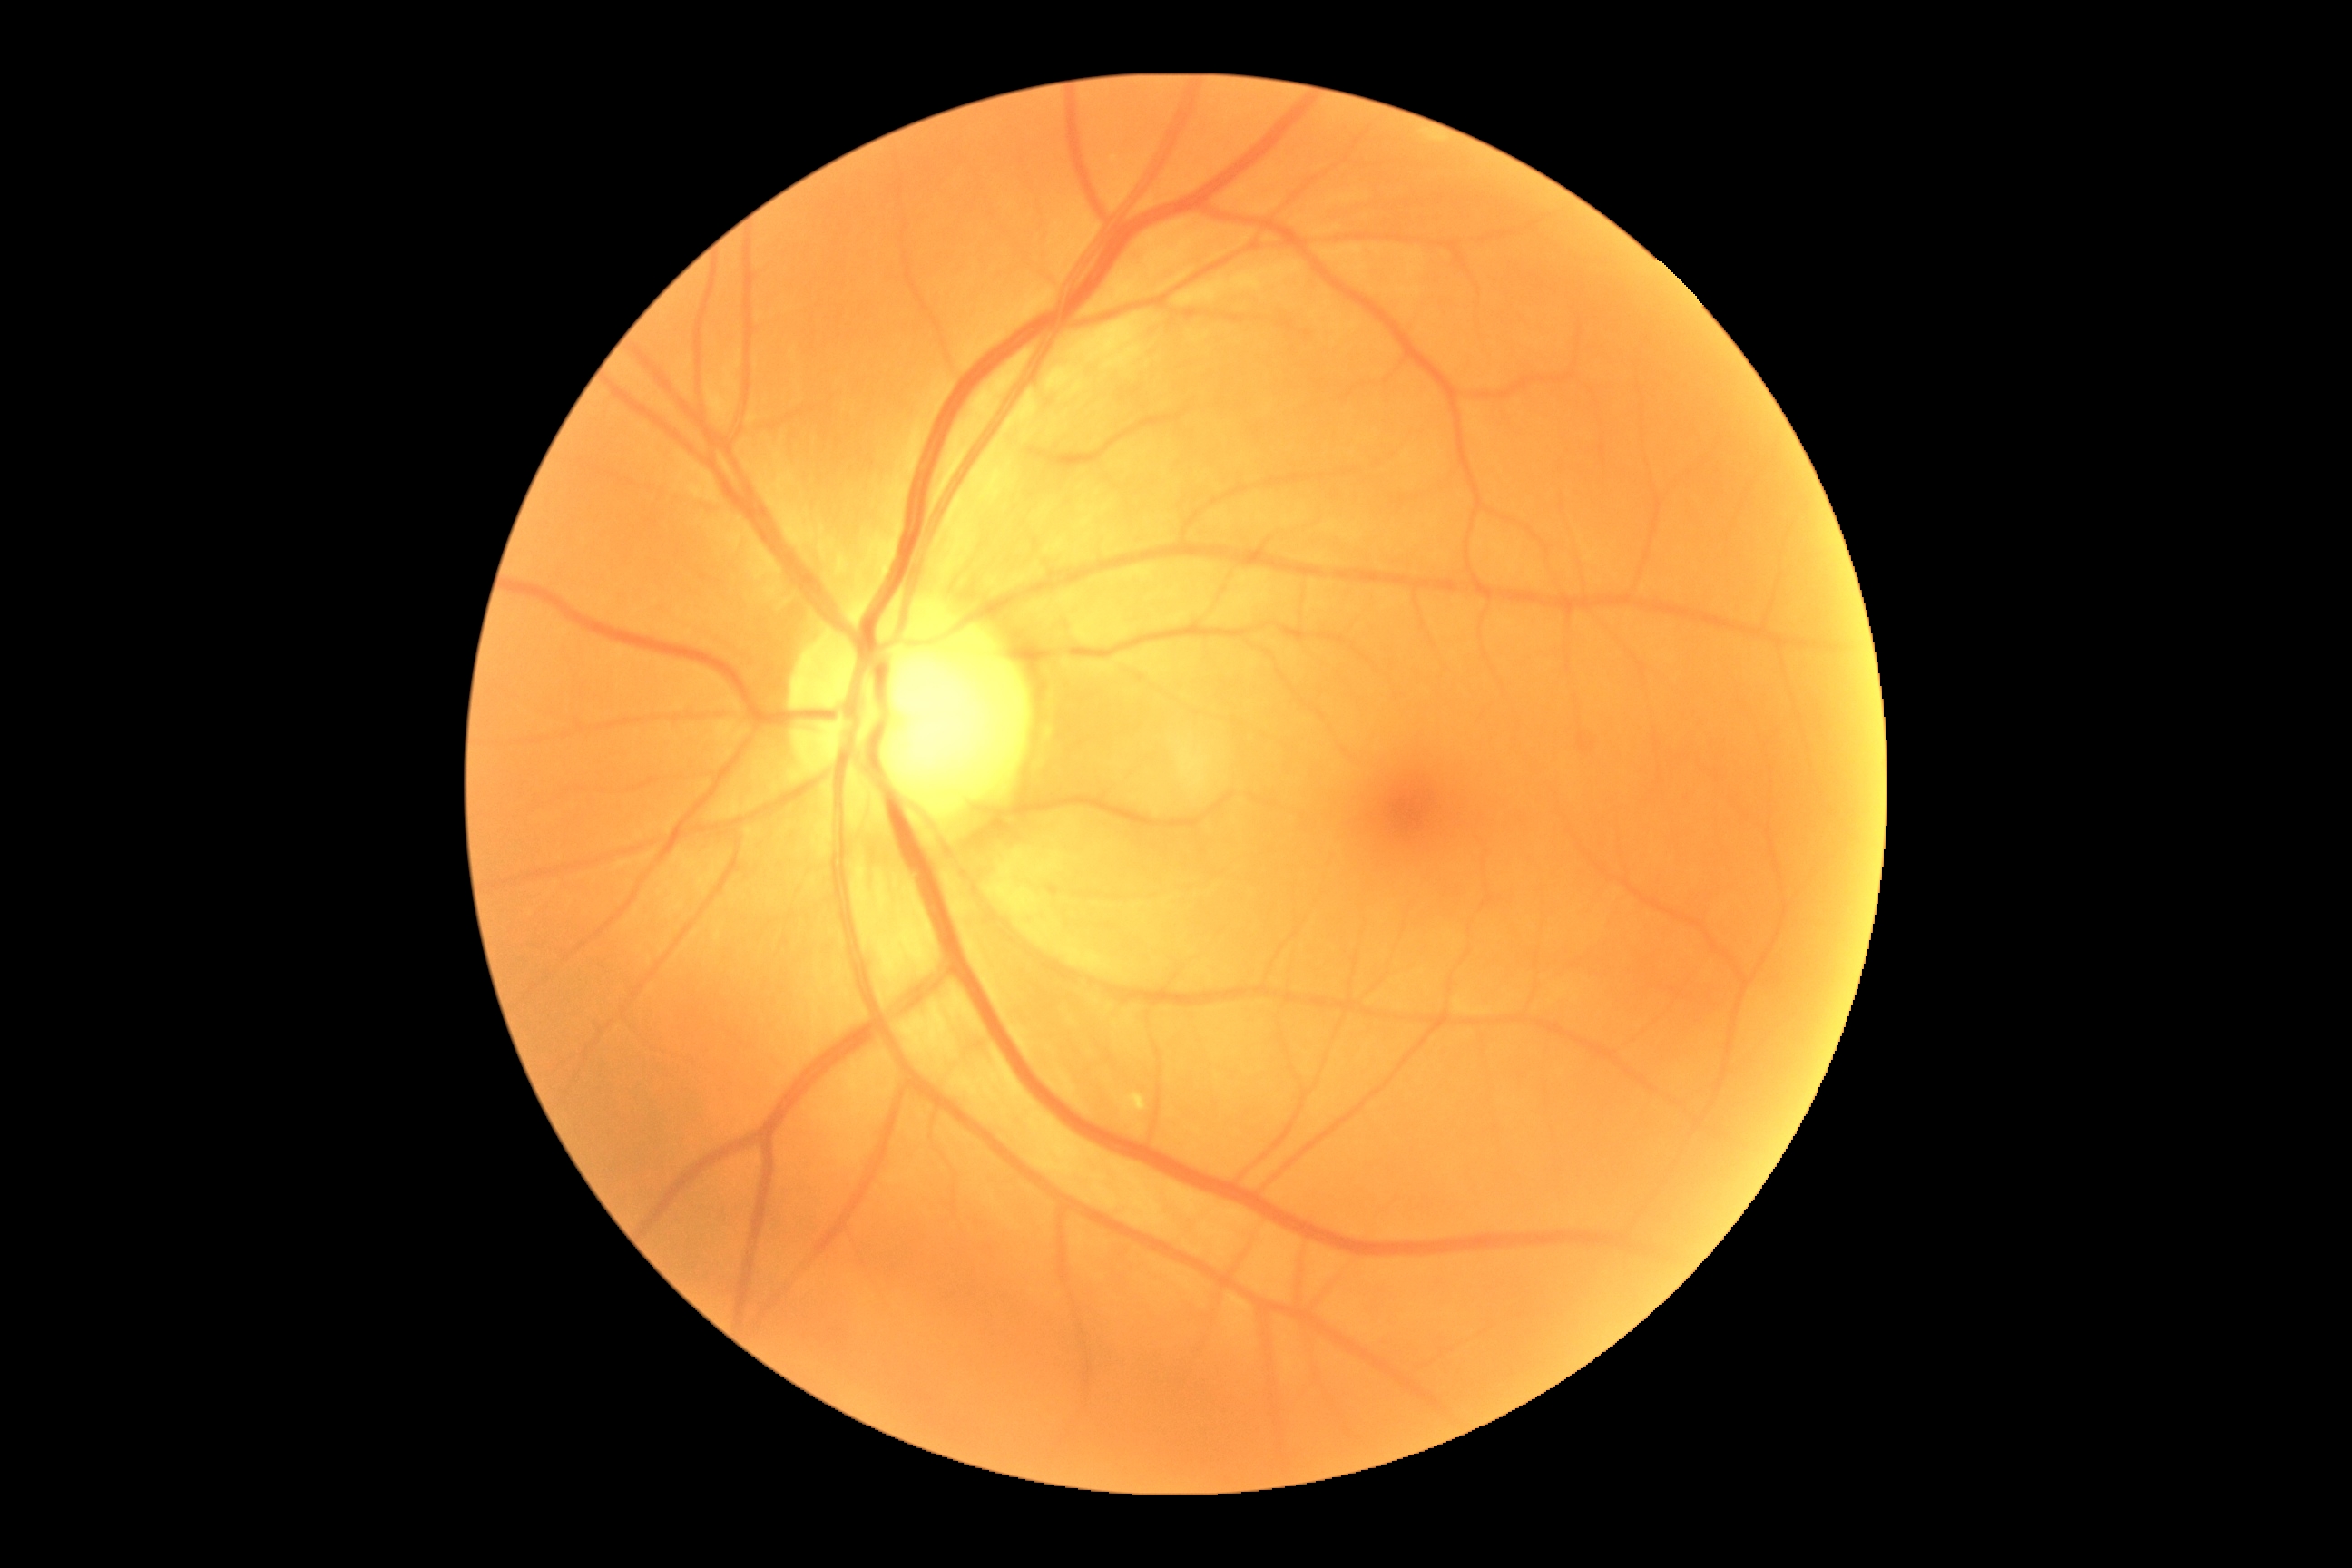
dr_grade: grade 0